Infant wide-field fundus photograph · camera: Phoenix ICON (100° FOV) — 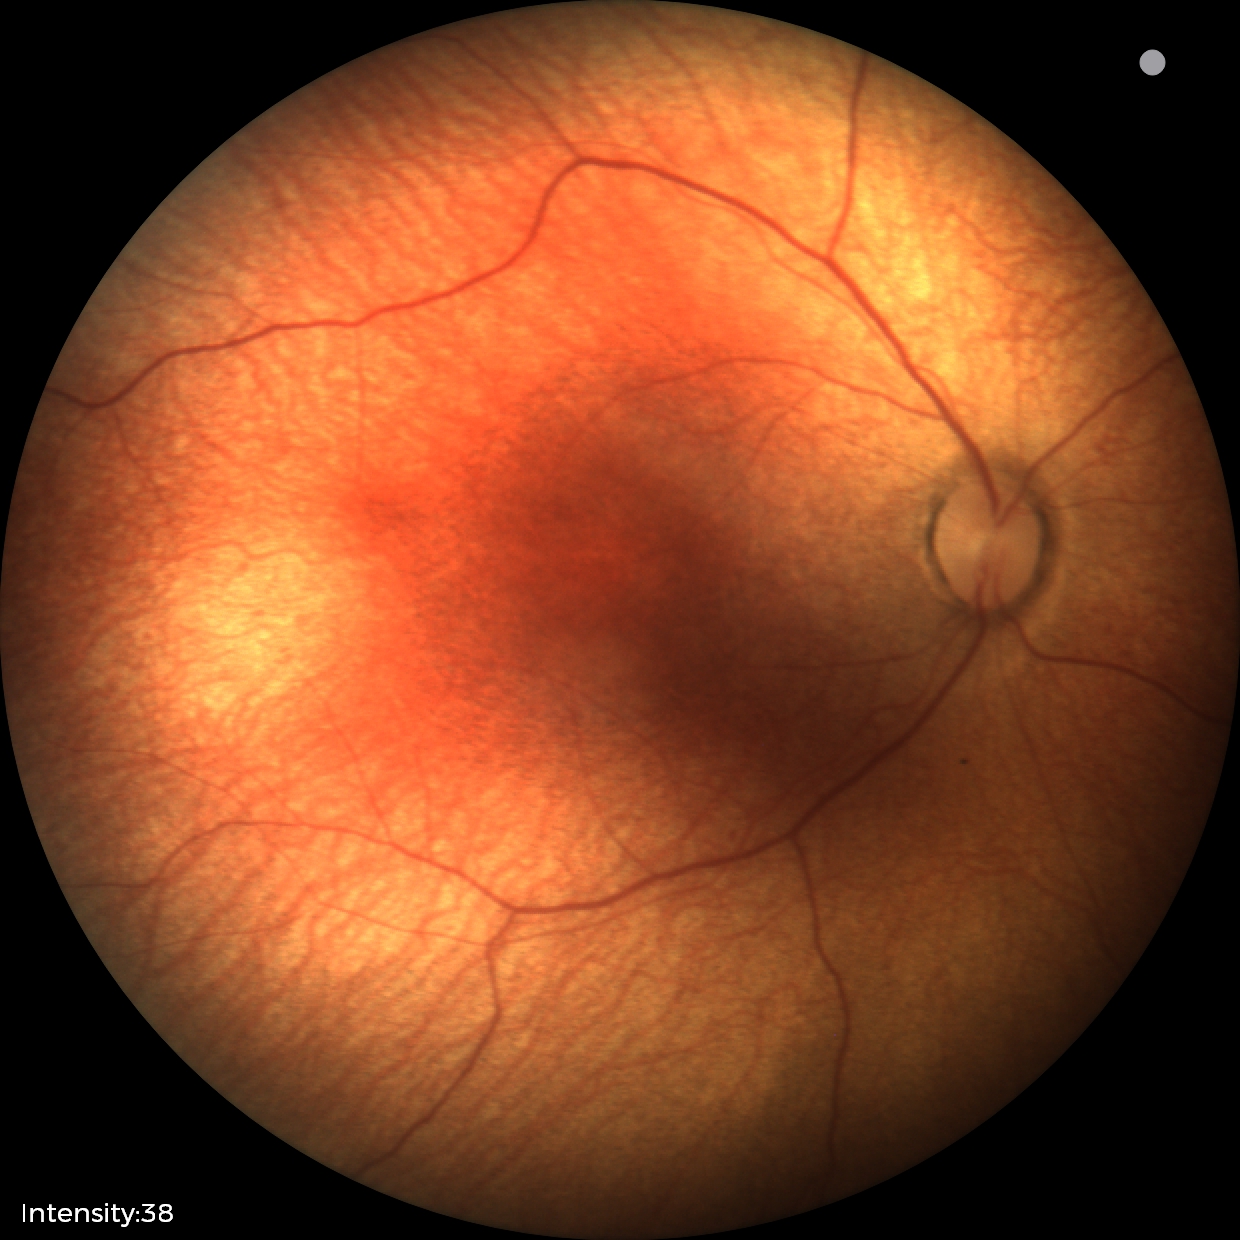
No retinal pathology identified on screening.